45 degree fundus photograph · diabetic retinopathy graded by the modified Davis classification — 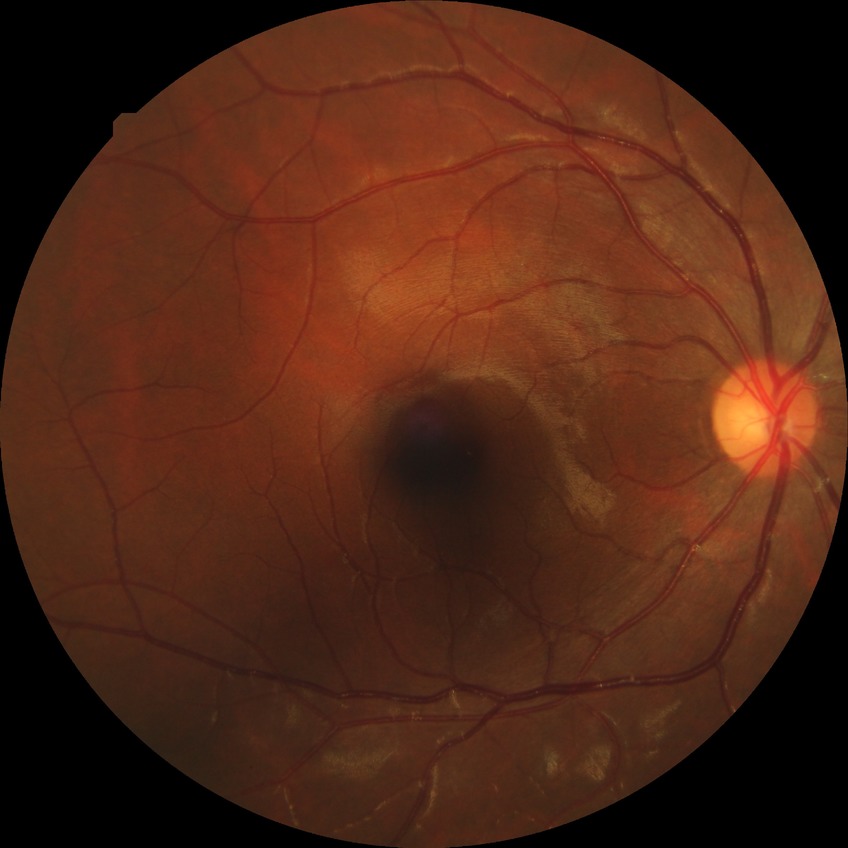 Diabetic retinopathy (DR) is NDR (no diabetic retinopathy).